Captured with the Natus RetCam Envision (130° field of view) · infant wide-field fundus photograph:
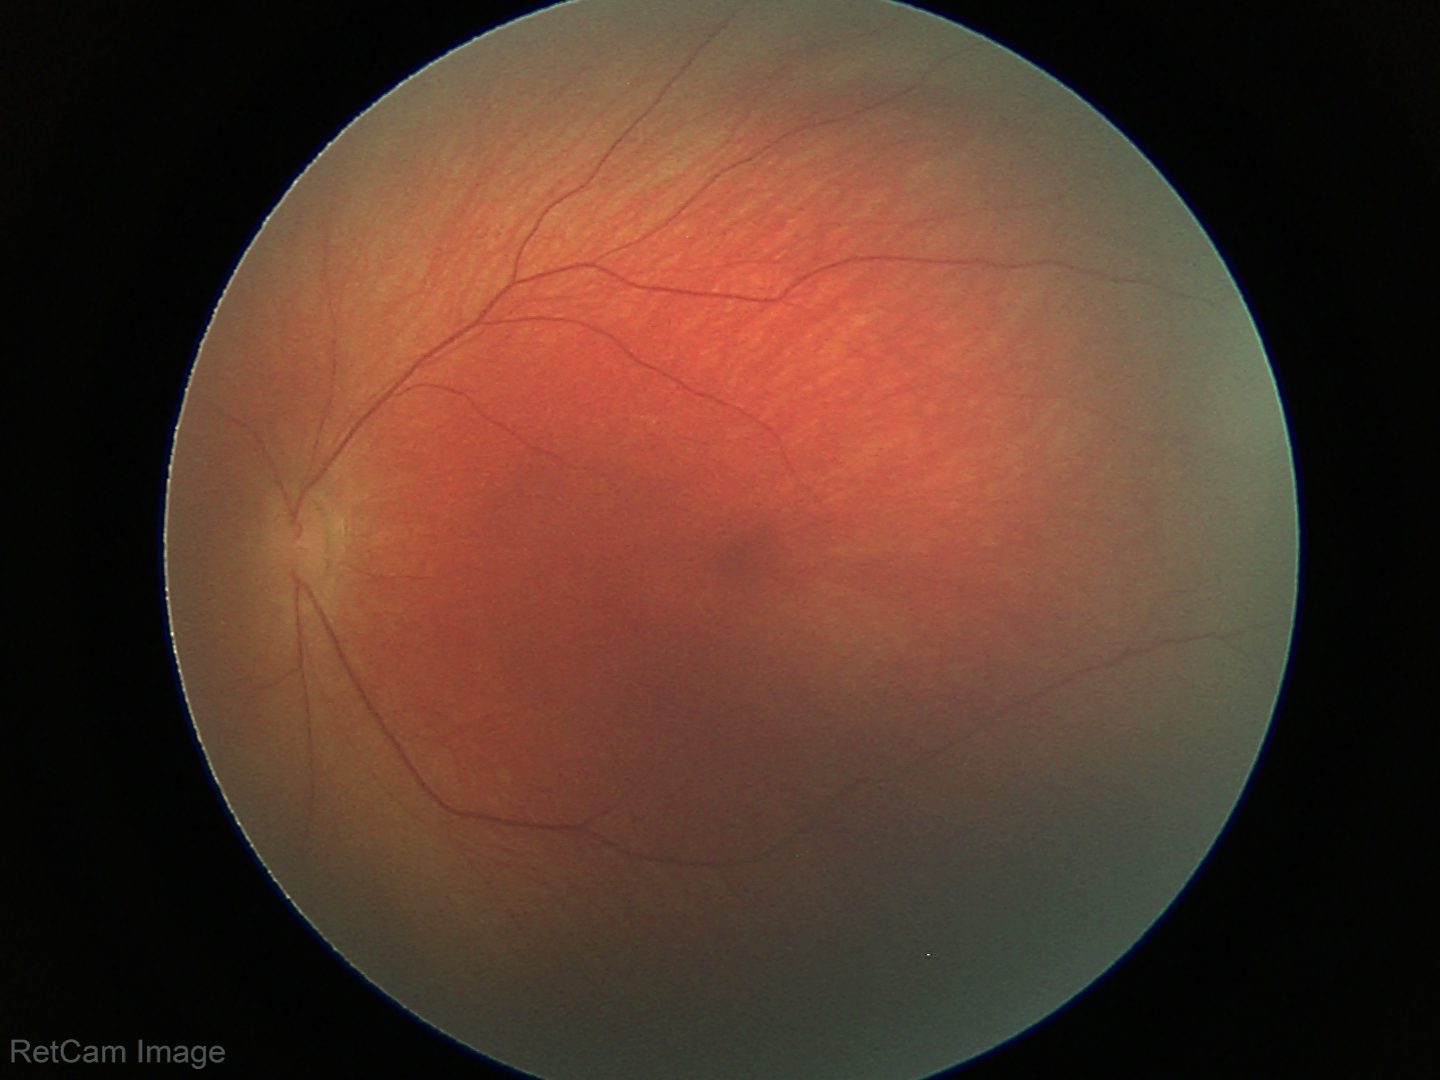
Impression: normal.